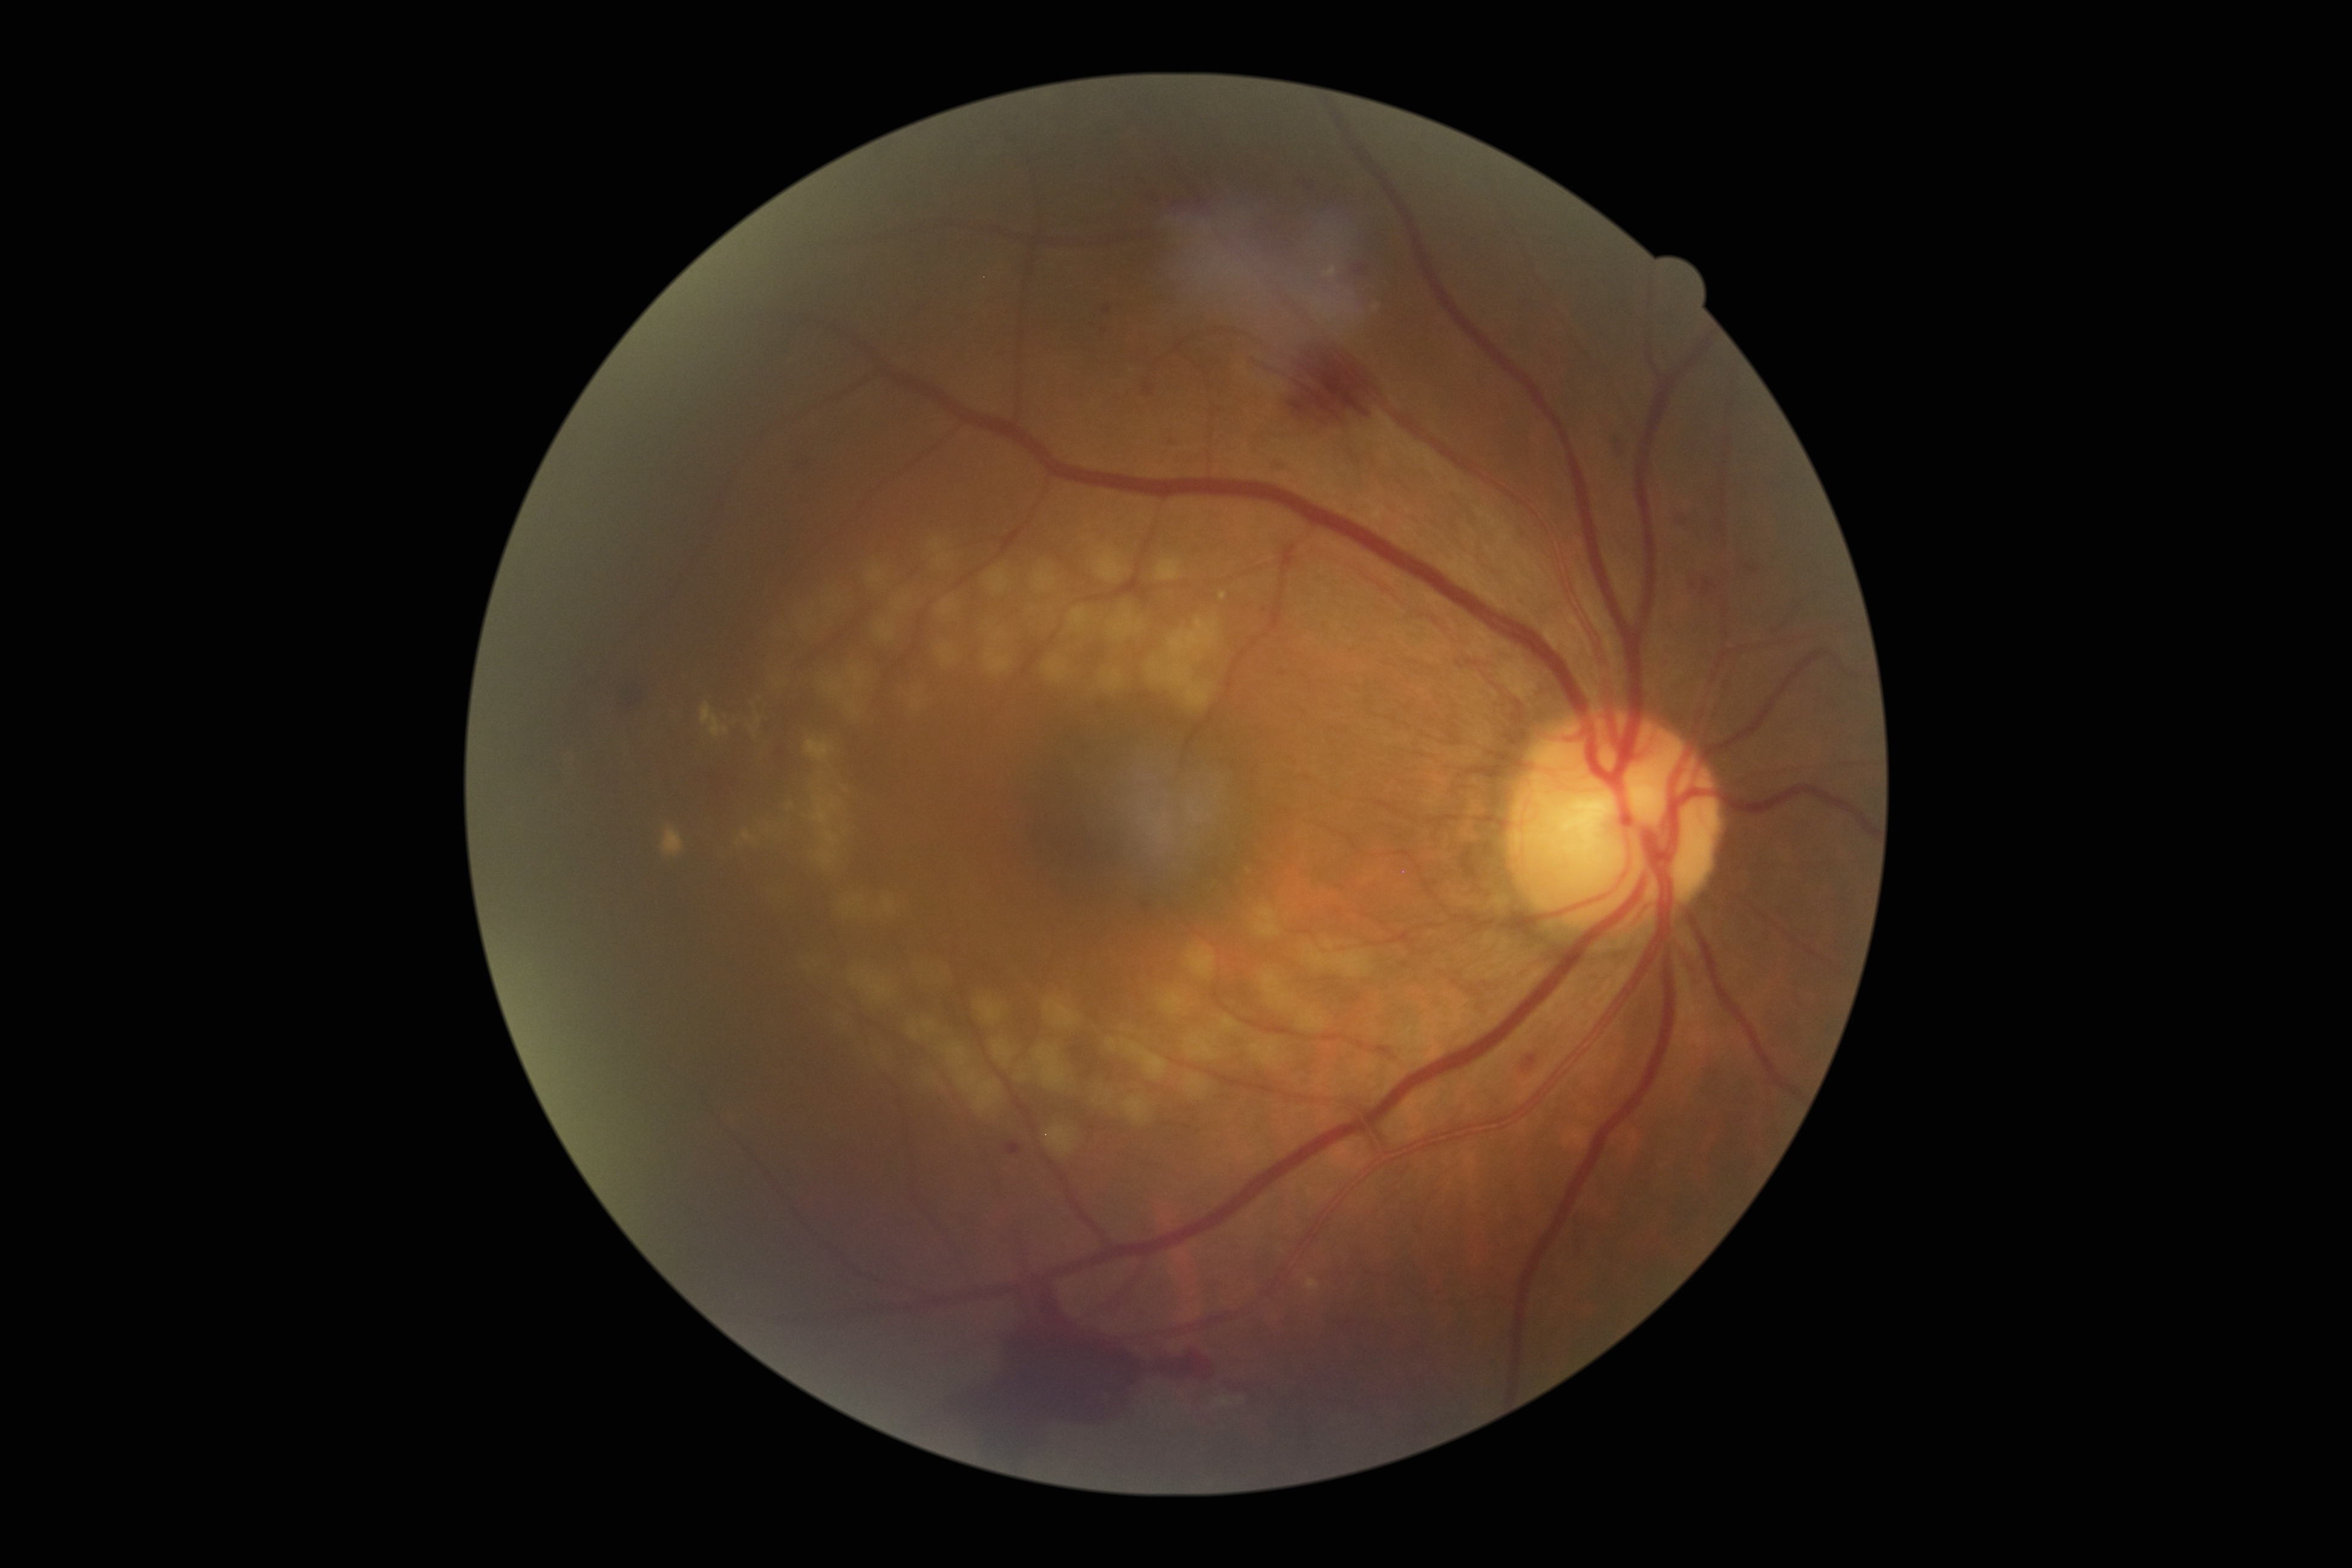
Annotations:
- diabetic retinopathy (DR) — 4/4